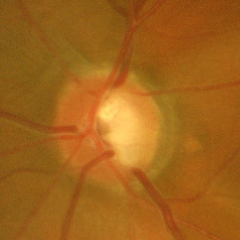 Glaucomatous changes are present. Glaucoma status = advanced glaucoma.